Acquired with a Remidio Fundus on Phone (FOP) camera; retinal fundus photograph; 1659 by 2212 pixels: 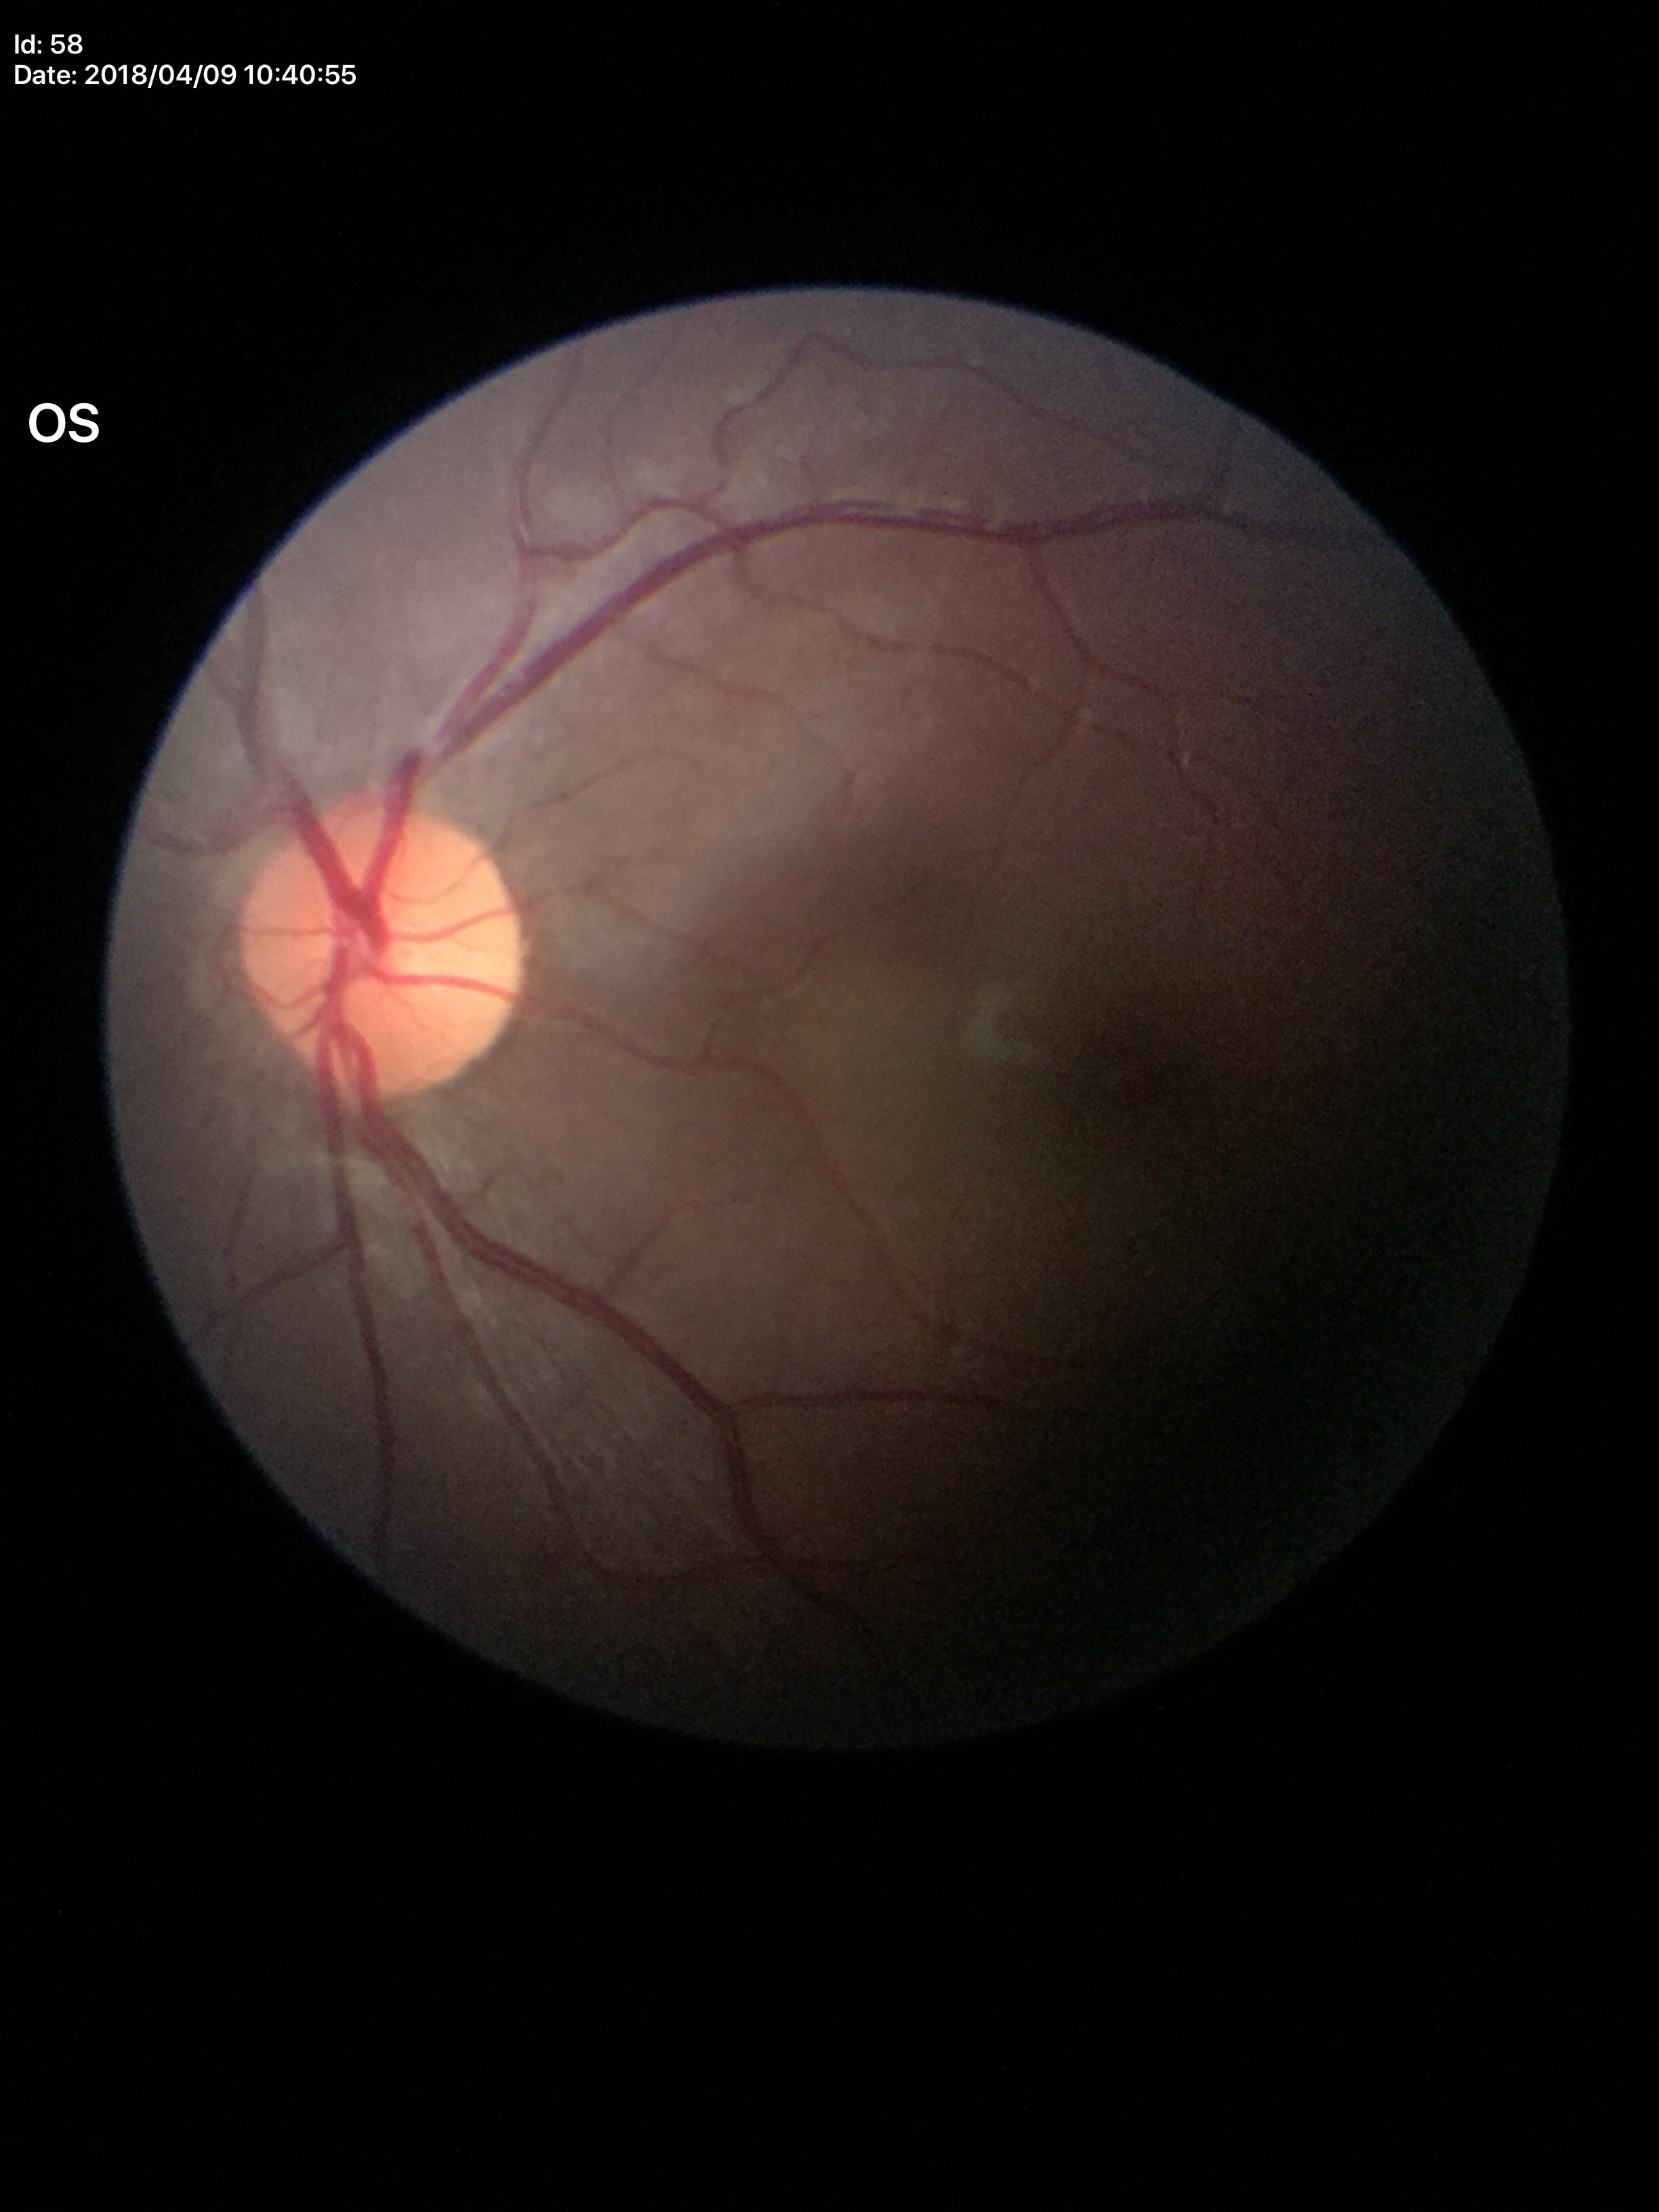
{"glaucoma_decision": "no suspicious findings (unanimous normal call)", "hcdr": "0.43", "vcdr": "0.41"}